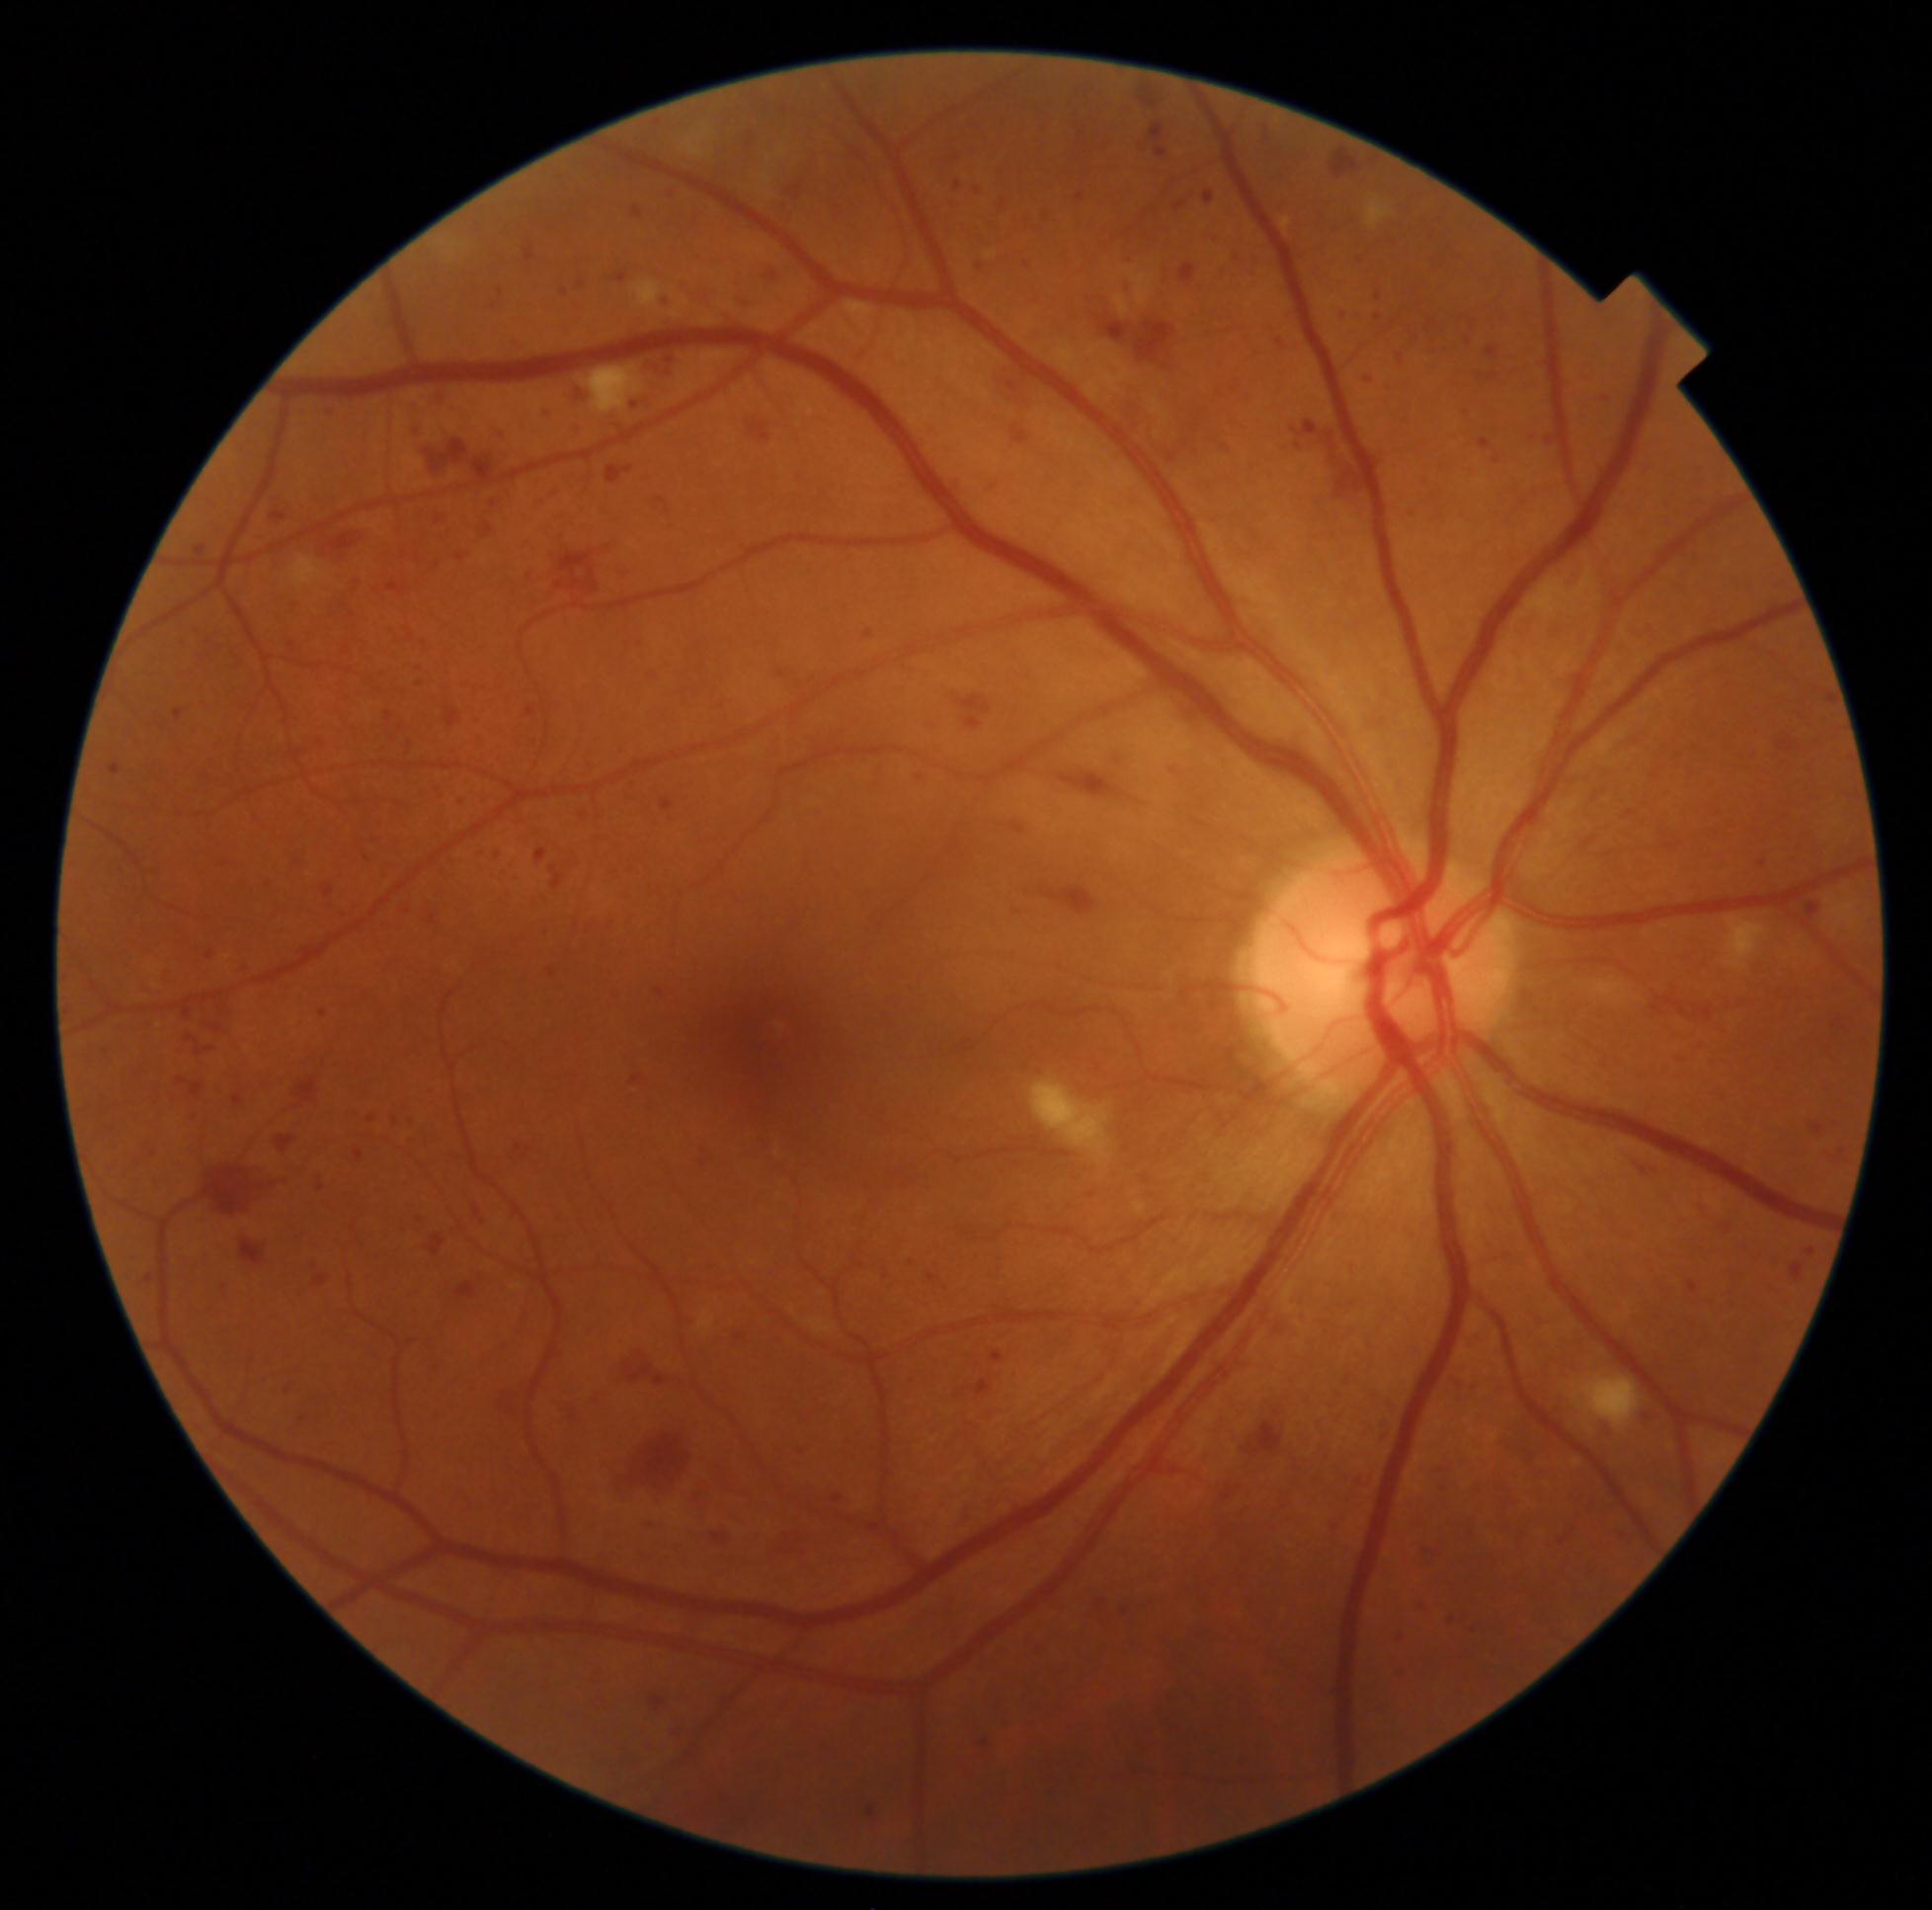 Diabetic retinopathy severity is grade 3 (severe NPDR); non-proliferative diabetic retinopathy
A subset of detected lesions:
hemorrhages (subset) = <region>1248, 253, 1264, 266</region> | <region>139, 1274, 157, 1290</region> | <region>991, 1352, 1004, 1363</region> | <region>577, 759, 599, 779</region> | <region>612, 1425, 693, 1507</region> | <region>1455, 408, 1473, 421</region> | <region>457, 554, 470, 562</region> | <region>1218, 1484, 1241, 1507</region> | <region>214, 905, 229, 916</region> | <region>225, 1229, 270, 1270</region> | <region>1173, 201, 1187, 212</region> | <region>1134, 78, 1165, 111</region> | <region>197, 651, 212, 667</region> | <region>425, 1233, 446, 1261</region> | <region>948, 476, 964, 496</region> | <region>316, 881, 338, 899</region> | <region>1828, 1149, 1850, 1164</region> | <region>386, 713, 393, 722</region>
Smaller hemorrhages around point(1469, 342) | point(495, 305)